Wide-field fundus image from infant ROP screening; 130° field of view (Clarity RetCam 3)
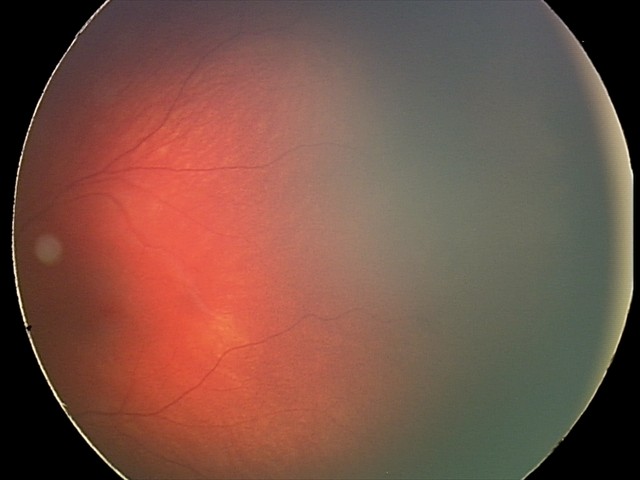 Screening: retinal hemorrhages.